1240x1240px · infant wide-field retinal image:
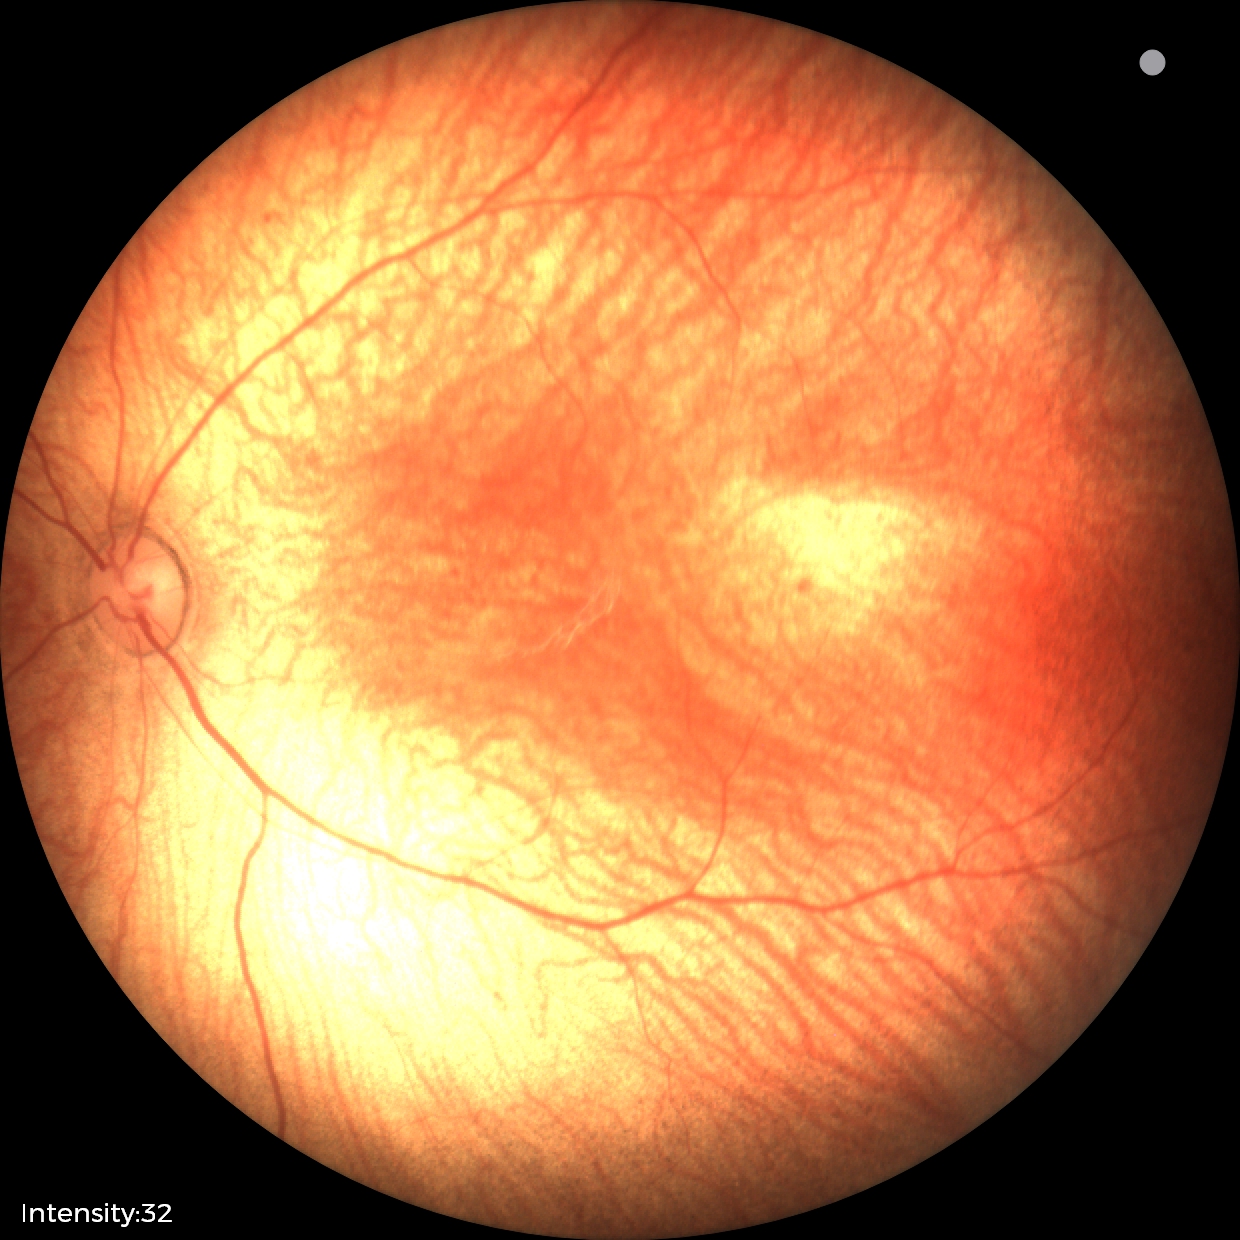 Physiological retinal appearance for postconceptual age.